Autorefraction: -1.75 -1 x 95 · patient age: 29 years · corneal thickness: 545 µm · IOP 15 mmHg (non-contact tonometry) · female: 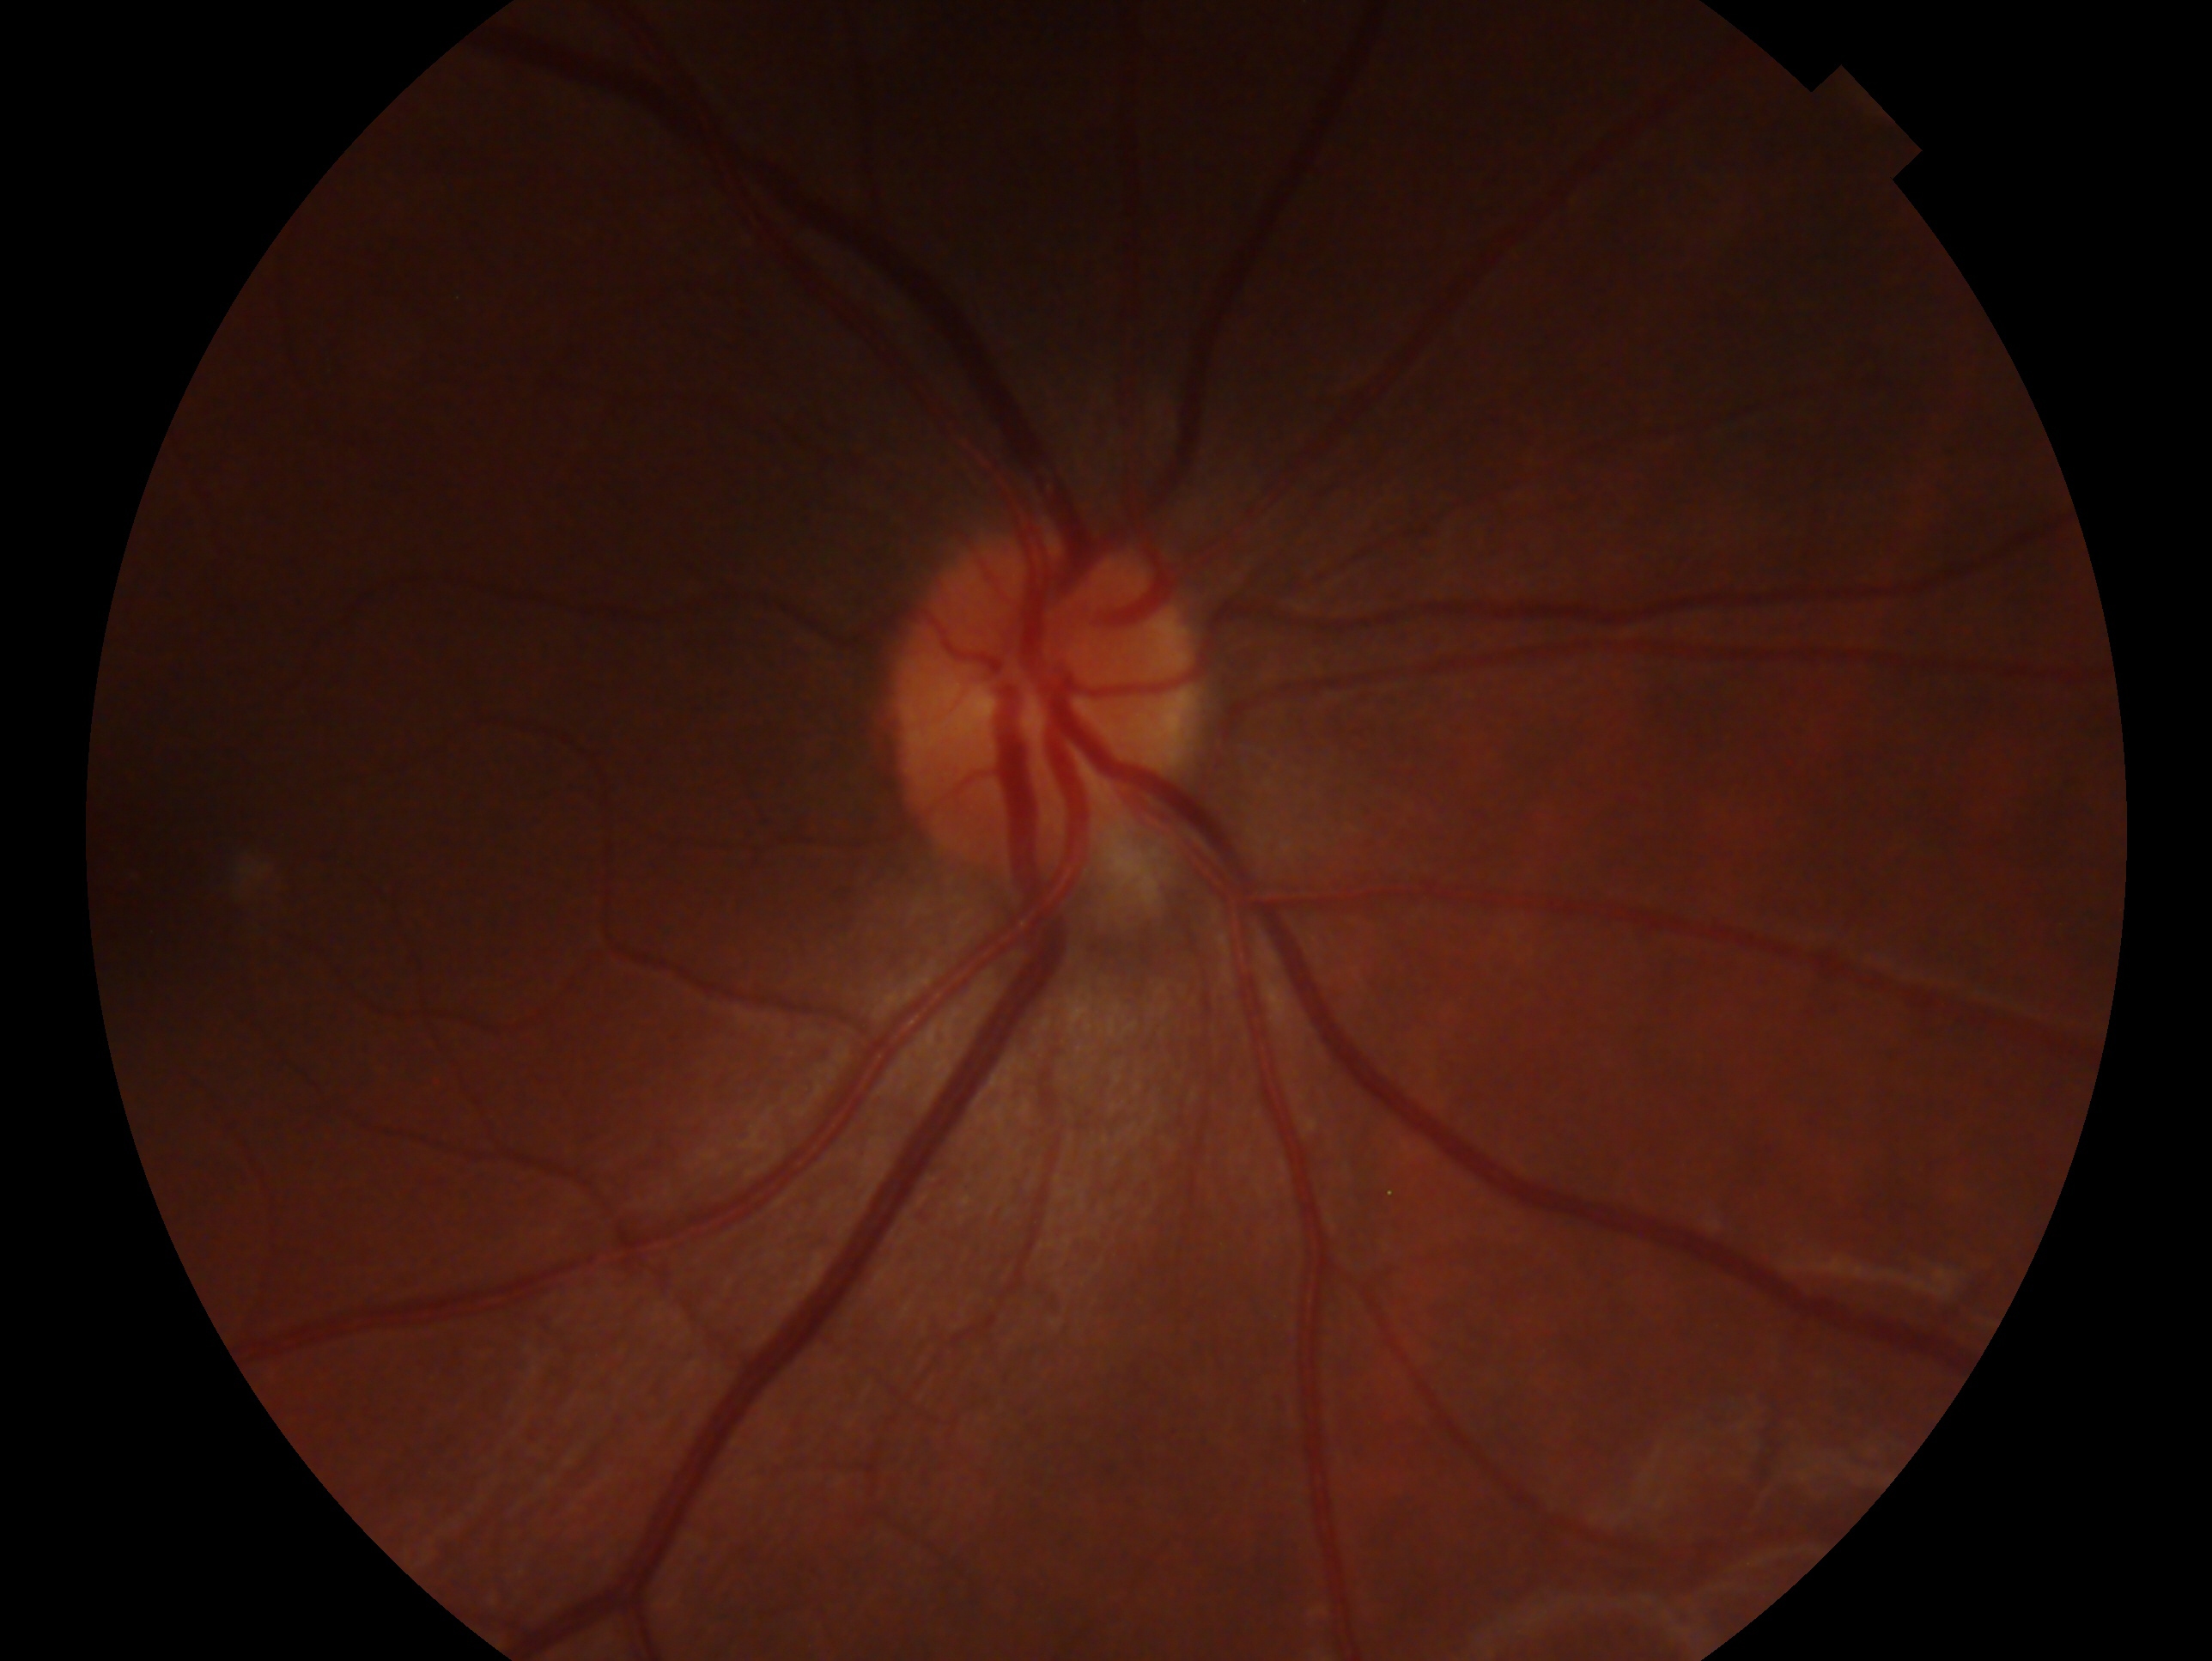
Eye: right eye.
Impression: no glaucoma — no clinical evidence of glaucoma in this eye.